Infant wide-field retinal image: 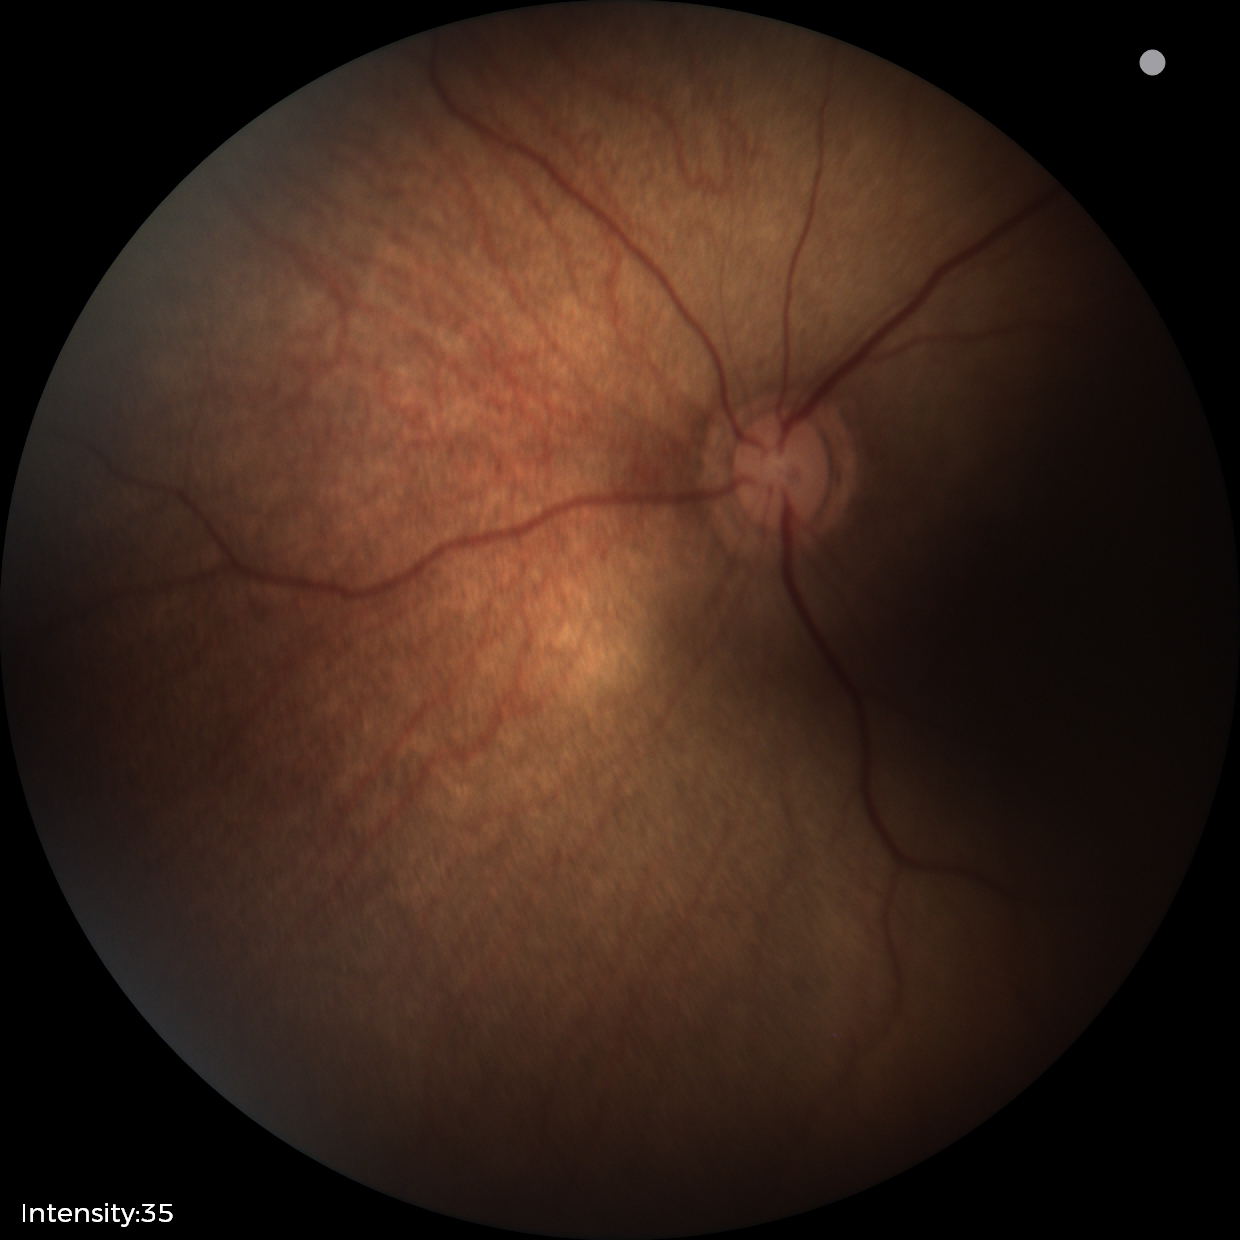 No retinal pathology identified on screening.